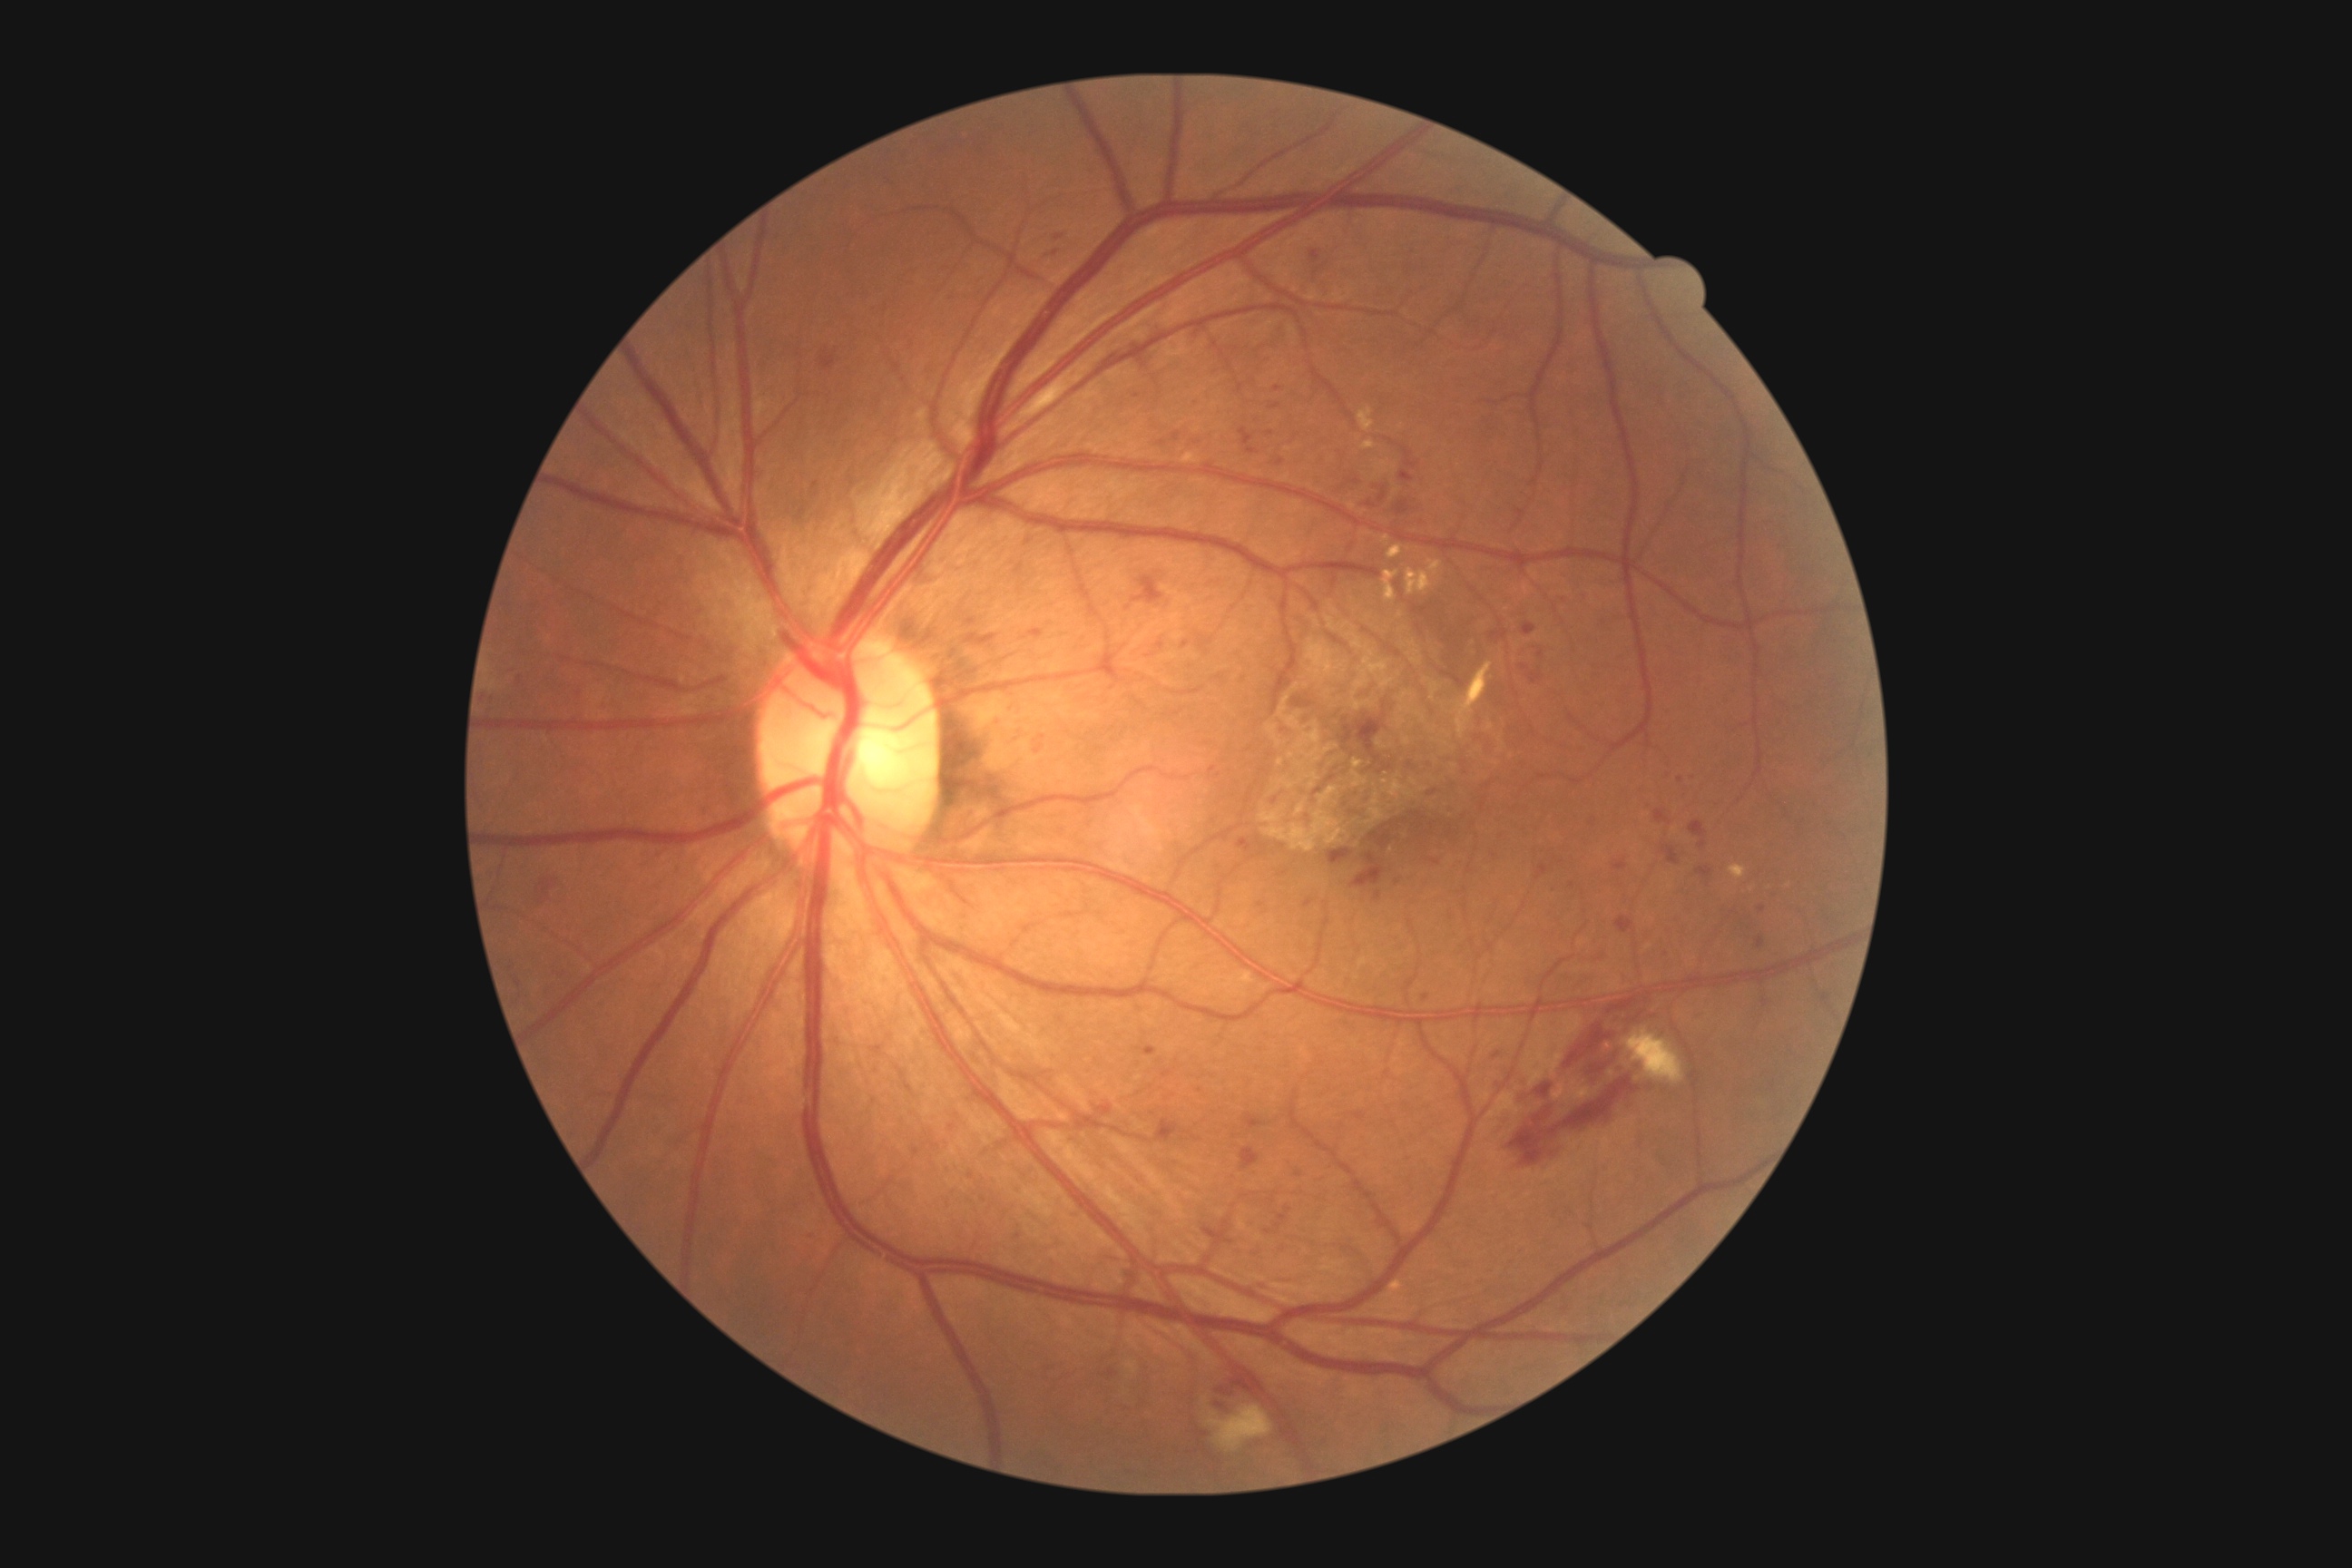

{
  "dr_category": "non-proliferative diabetic retinopathy",
  "dr_grade": "2 (moderate NPDR)"
}